FOV: 45 degrees, 1380x1382px — 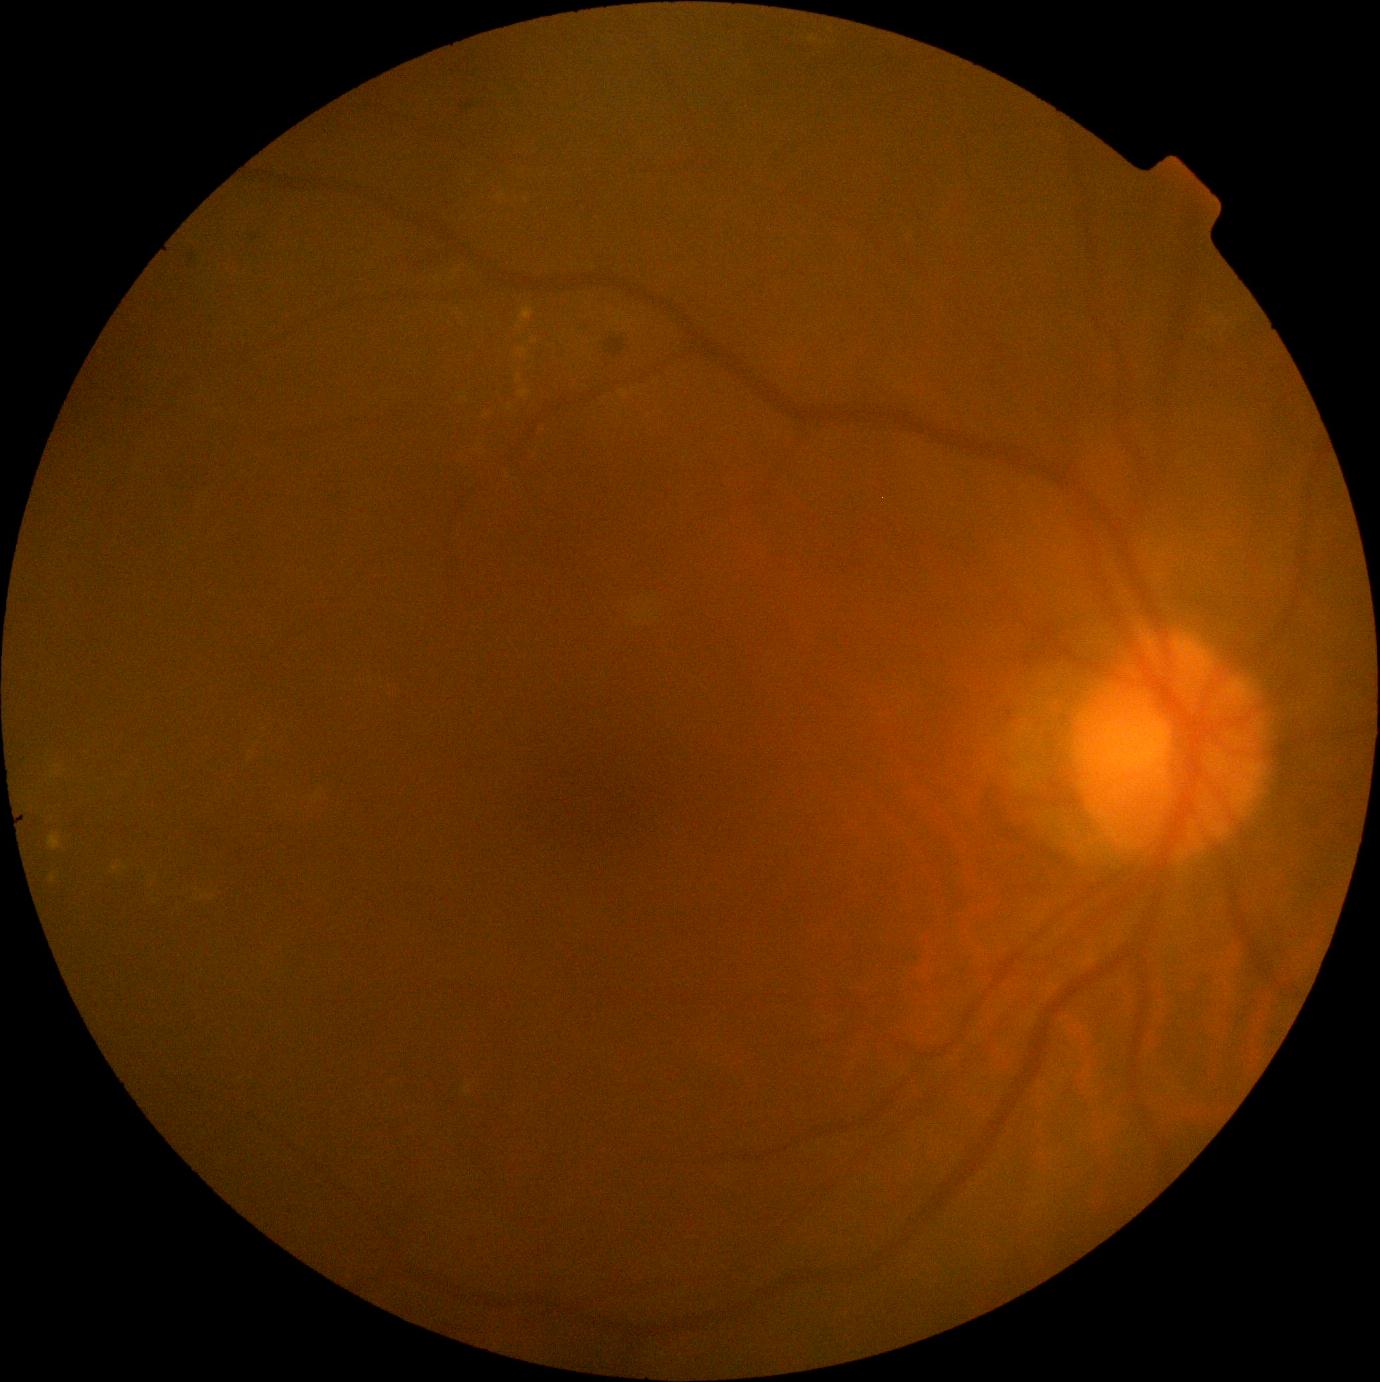 Retinopathy is 2.